Color fundus image. 45° FOV. 2212 by 1659 pixels
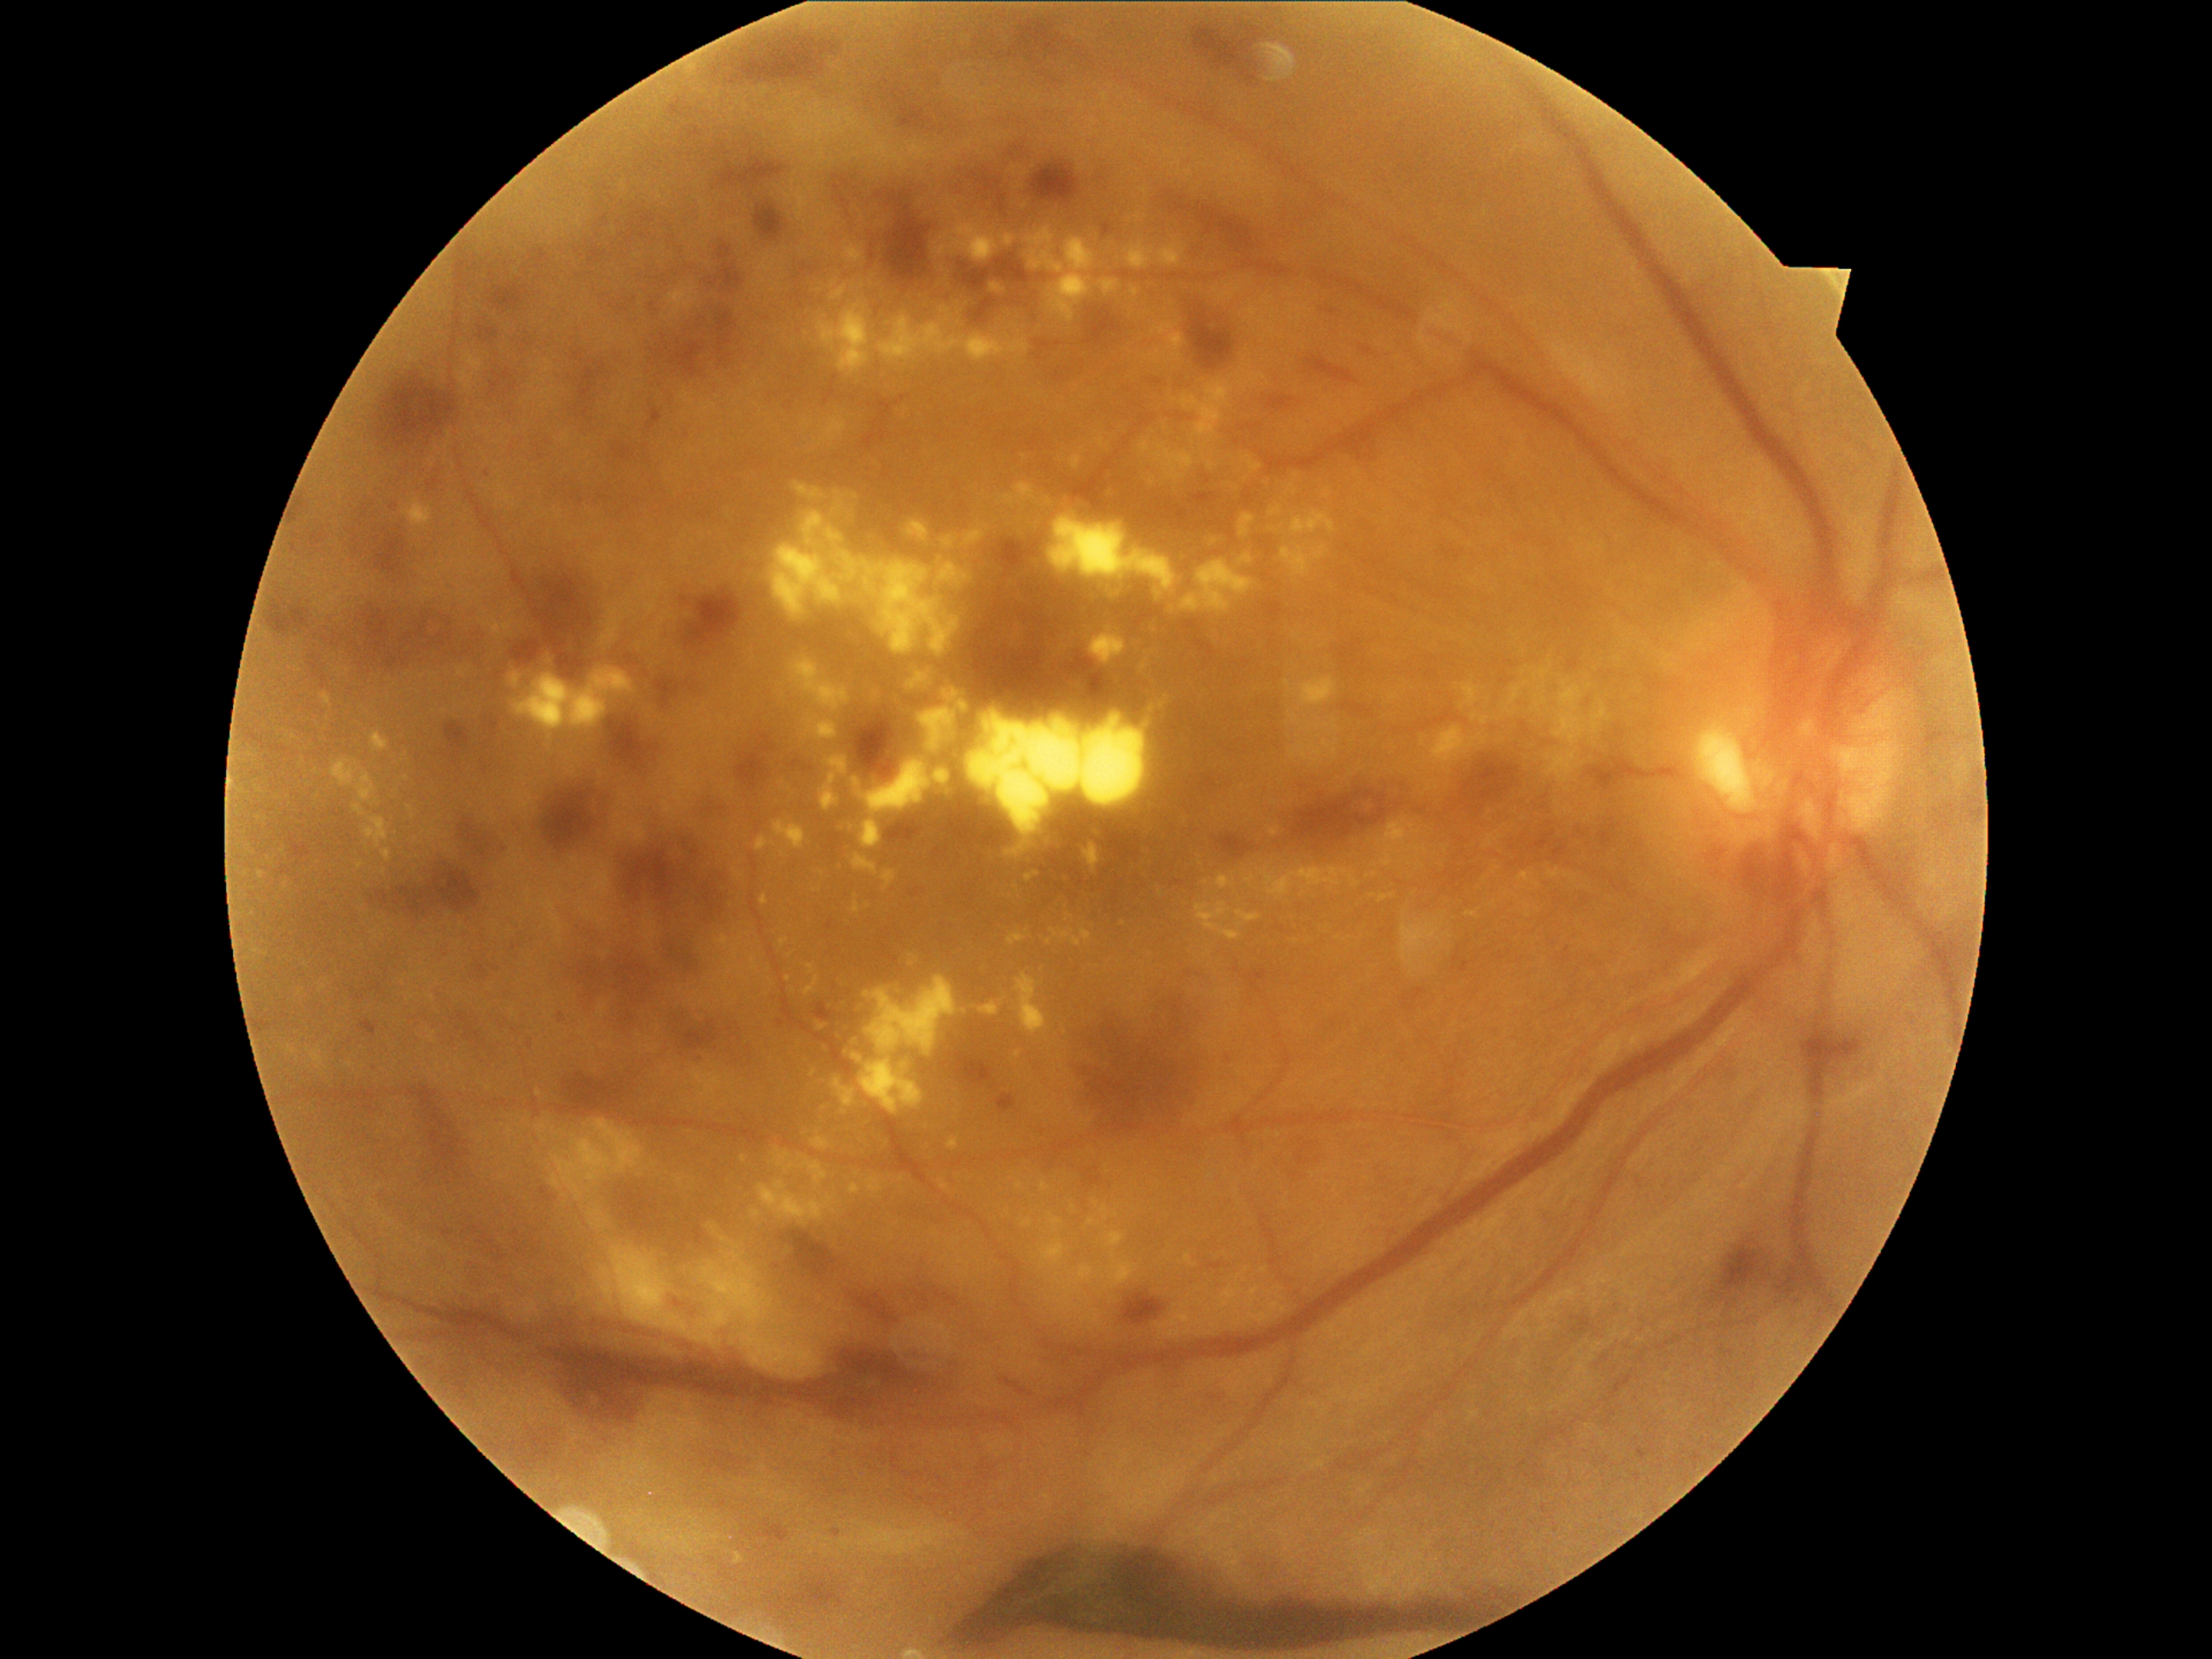 DR severity: proliferative diabetic retinopathy (grade 4).
HEs include lesions at 1189,311,1233,370; 537,777,619,851; 851,714,897,781; 909,1279,969,1318; 1737,844,1808,904; 525,1330,882,1424; 998,538,1040,571; 735,735,776,789; 409,1100,463,1182; 269,602,311,637; 684,590,743,649; 656,677,680,709; 960,264,991,293; 1288,779,1411,849; 755,201,786,242; 972,644,1122,719; 817,1003,835,1022.
EXs include lesions at 1163,422,1170,433; 288,1045,296,1056; 844,247,864,264; 1260,866,1361,899; 853,854,878,875; 853,975,958,1115; 849,1184,861,1194; 812,1138,830,1150; 1126,243,1155,272; 1025,871,1040,882; 1049,1214,1064,1233; 1283,545,1329,576.
Additional small EXs near 1264, 1271; 854, 287; 1298, 636; 1296, 941; 902, 1179; 1028, 934; 769, 982; 349, 1065.
MAs include lesions at 1127,692,1148,713; 289,837,313,859; 718,242,731,262; 969,172,979,180; 648,409,663,433; 1329,310,1337,315; 1720,1346,1733,1358; 1264,395,1296,414; 479,327,499,342; 789,1583,846,1609; 977,168,1003,194; 876,192,885,199; 1638,1450,1648,1462; 1049,368,1066,381; 491,965,501,972.
Additional small MAs near 1228, 1058; 961, 193.